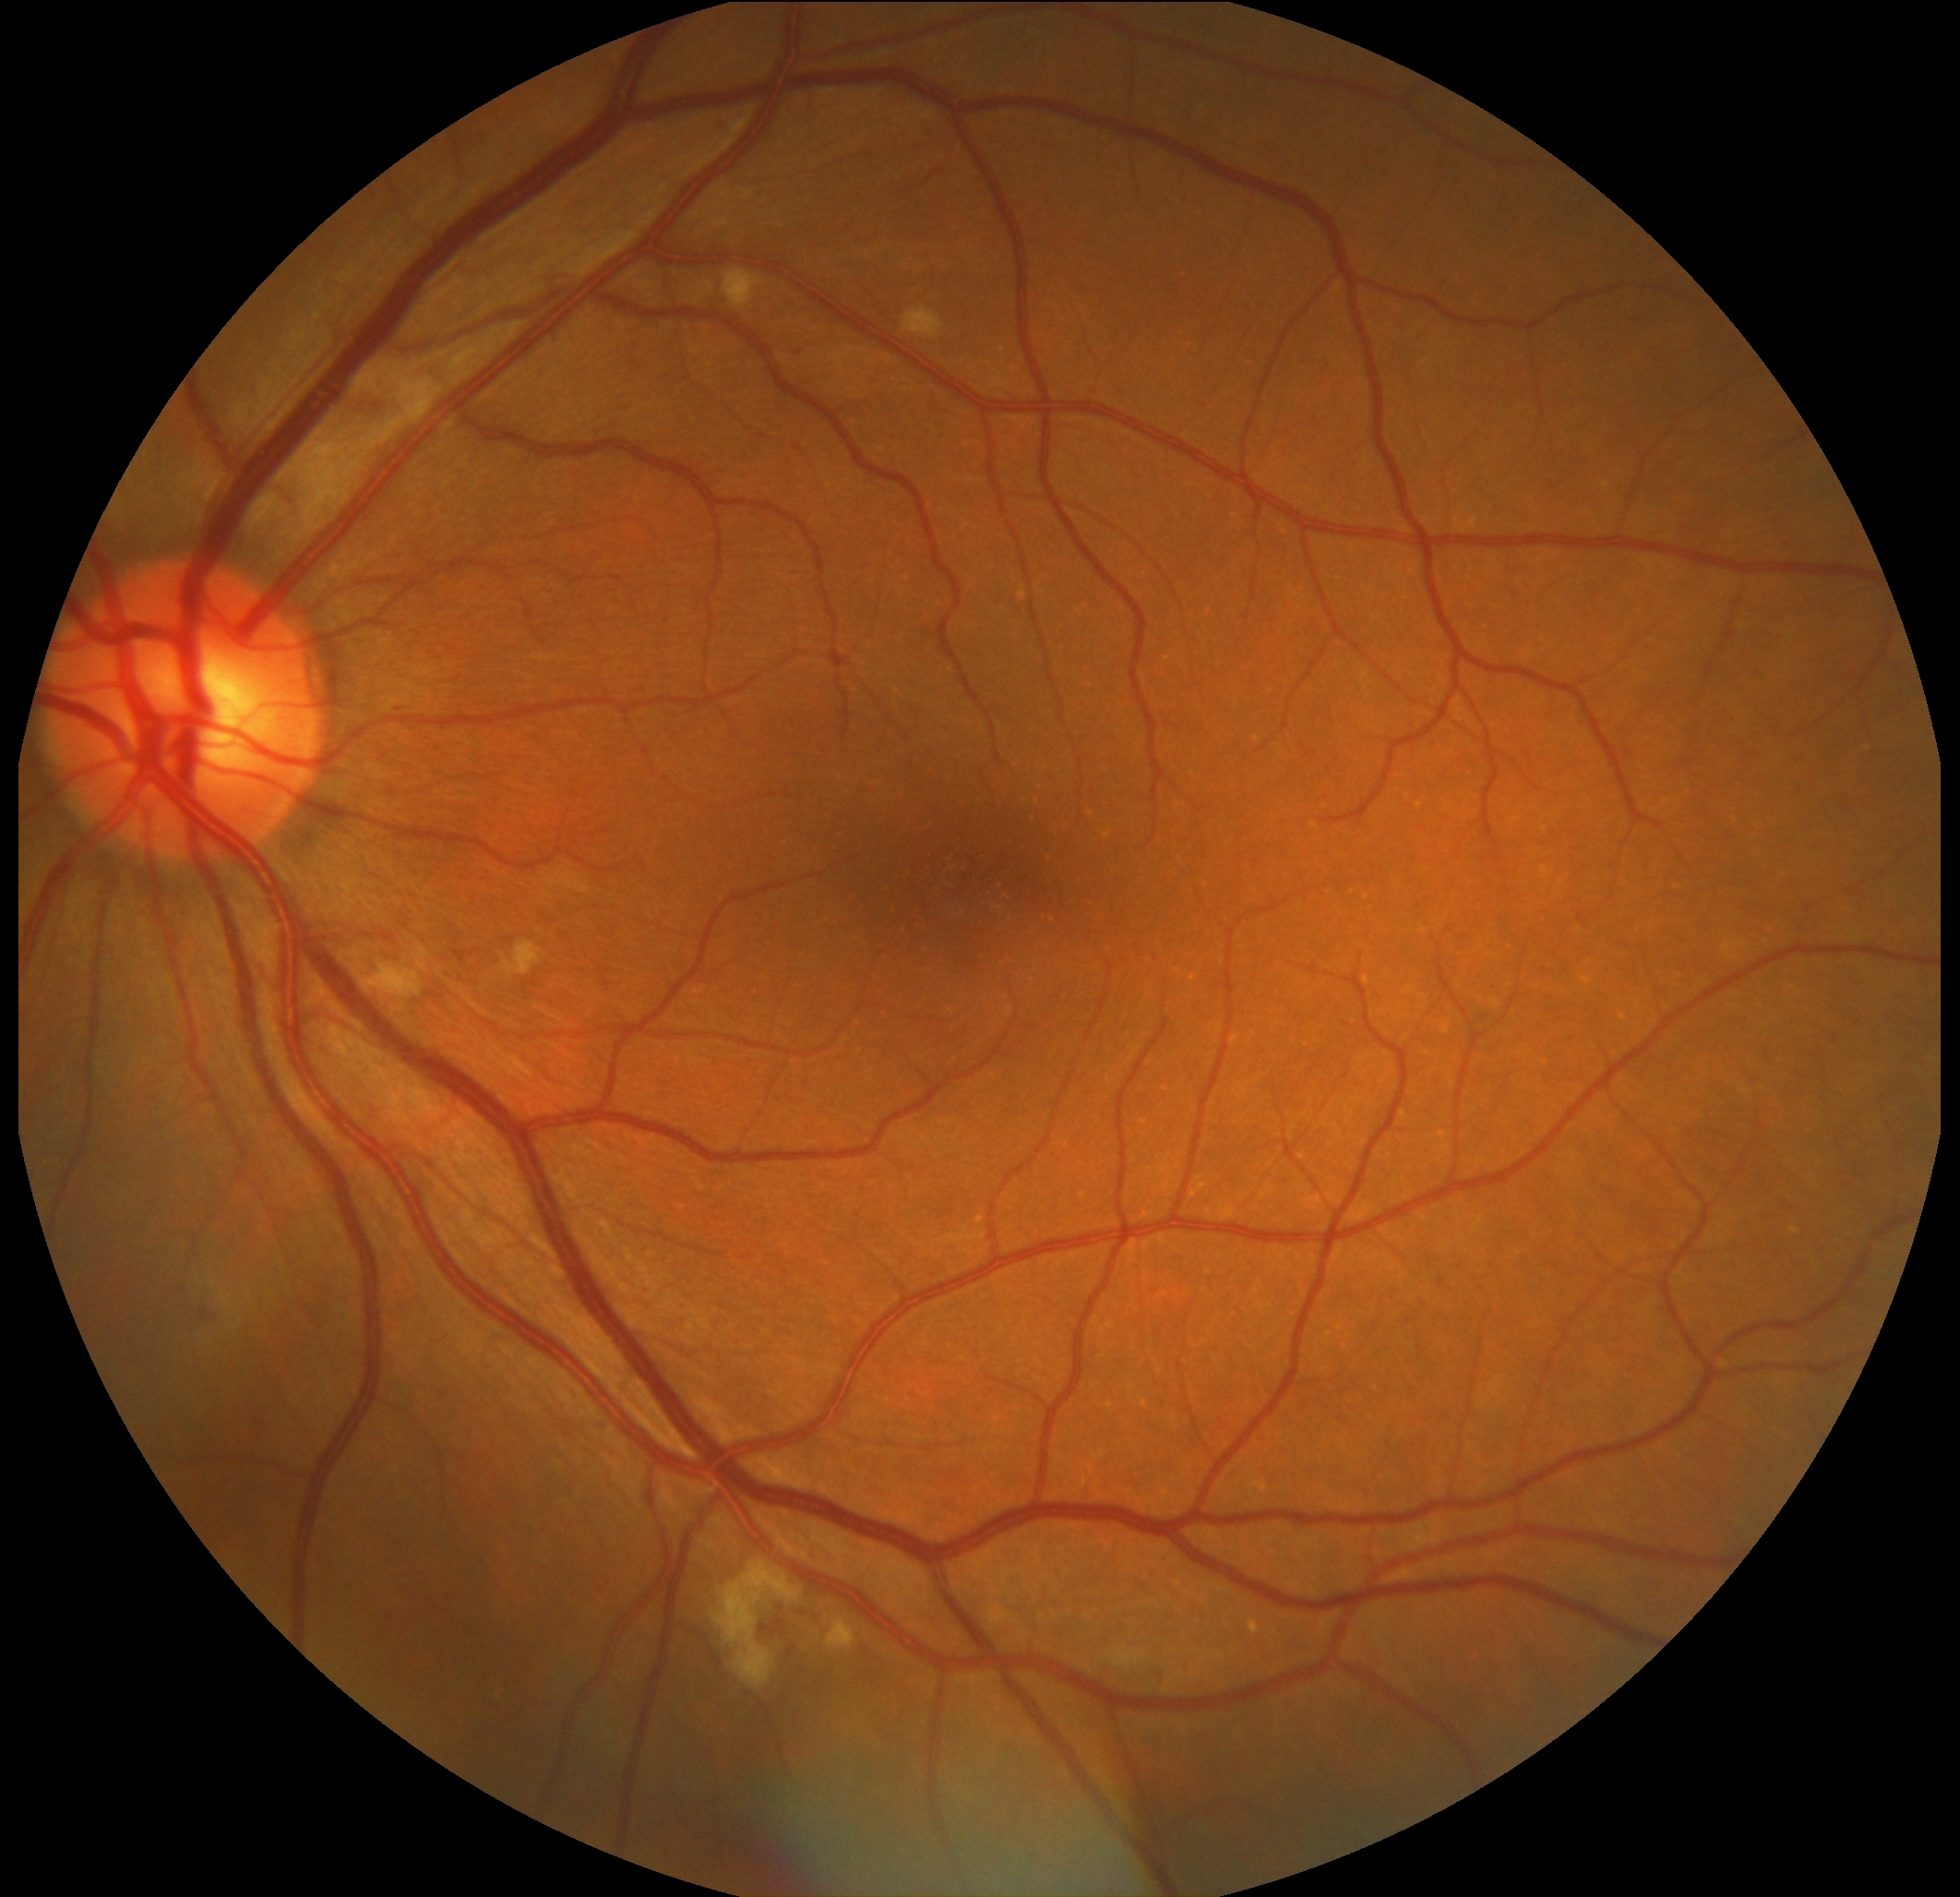
Retinopathy grade: 2 (moderate NPDR).